Davis DR grading — 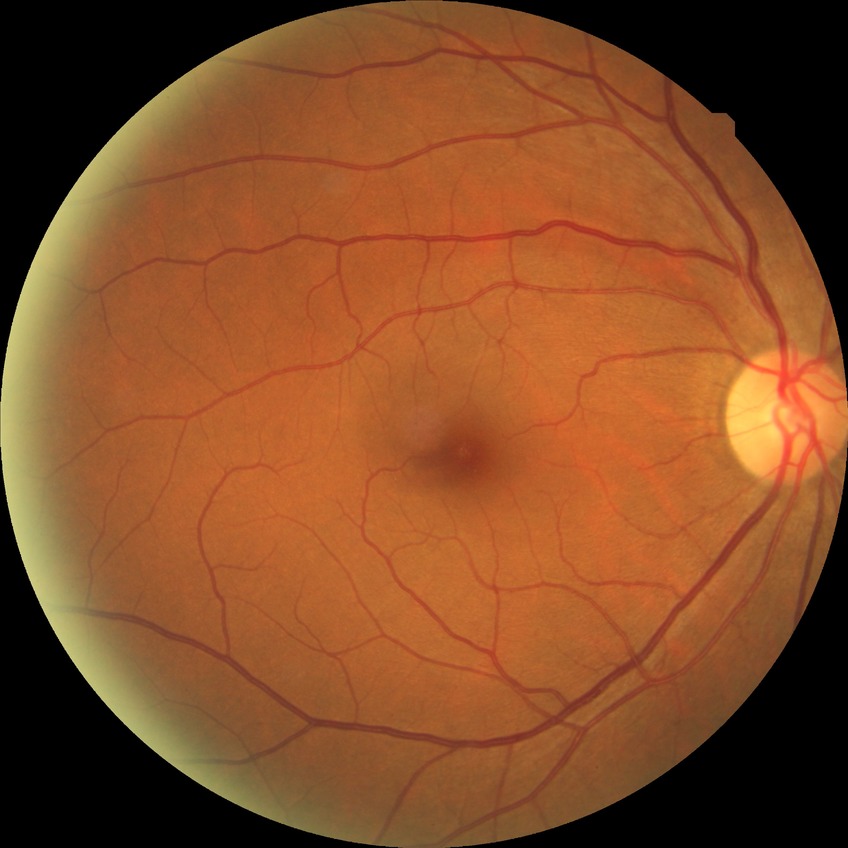 Assessment:
– Davis stage — NDR